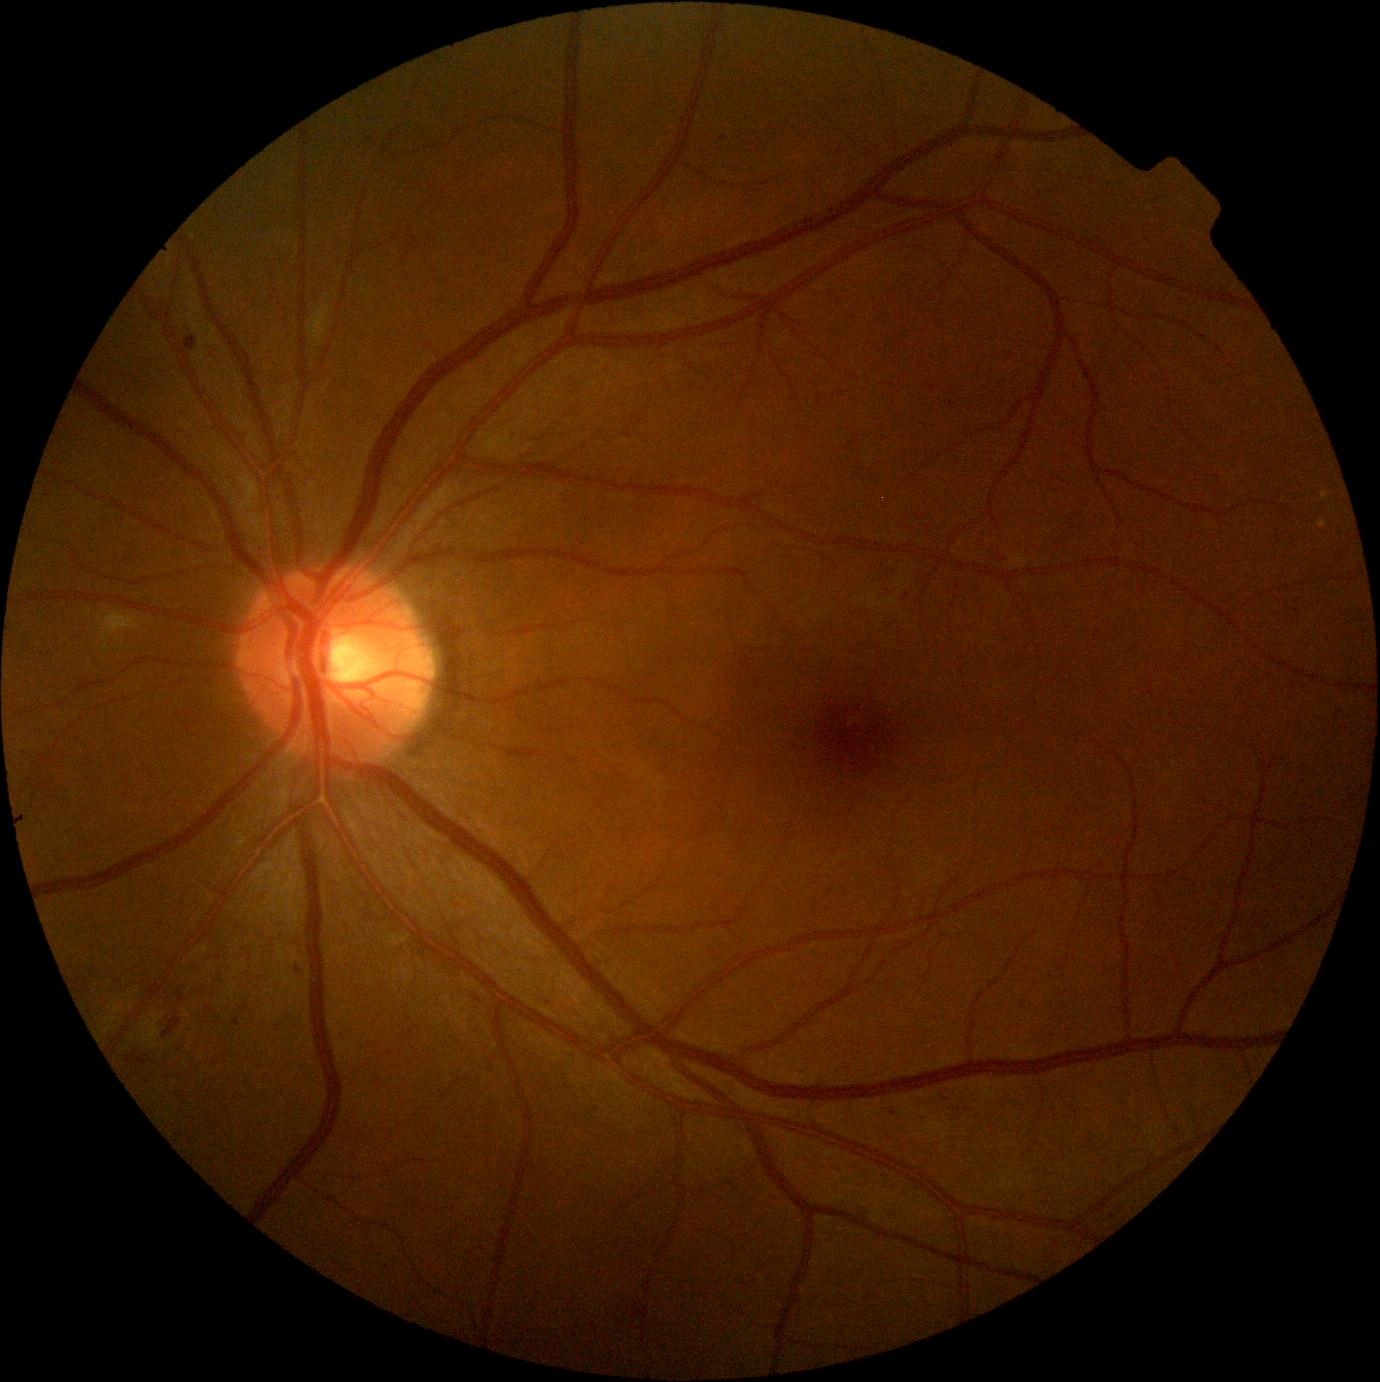 DR stage=moderate non-proliferative diabetic retinopathy (grade 2).